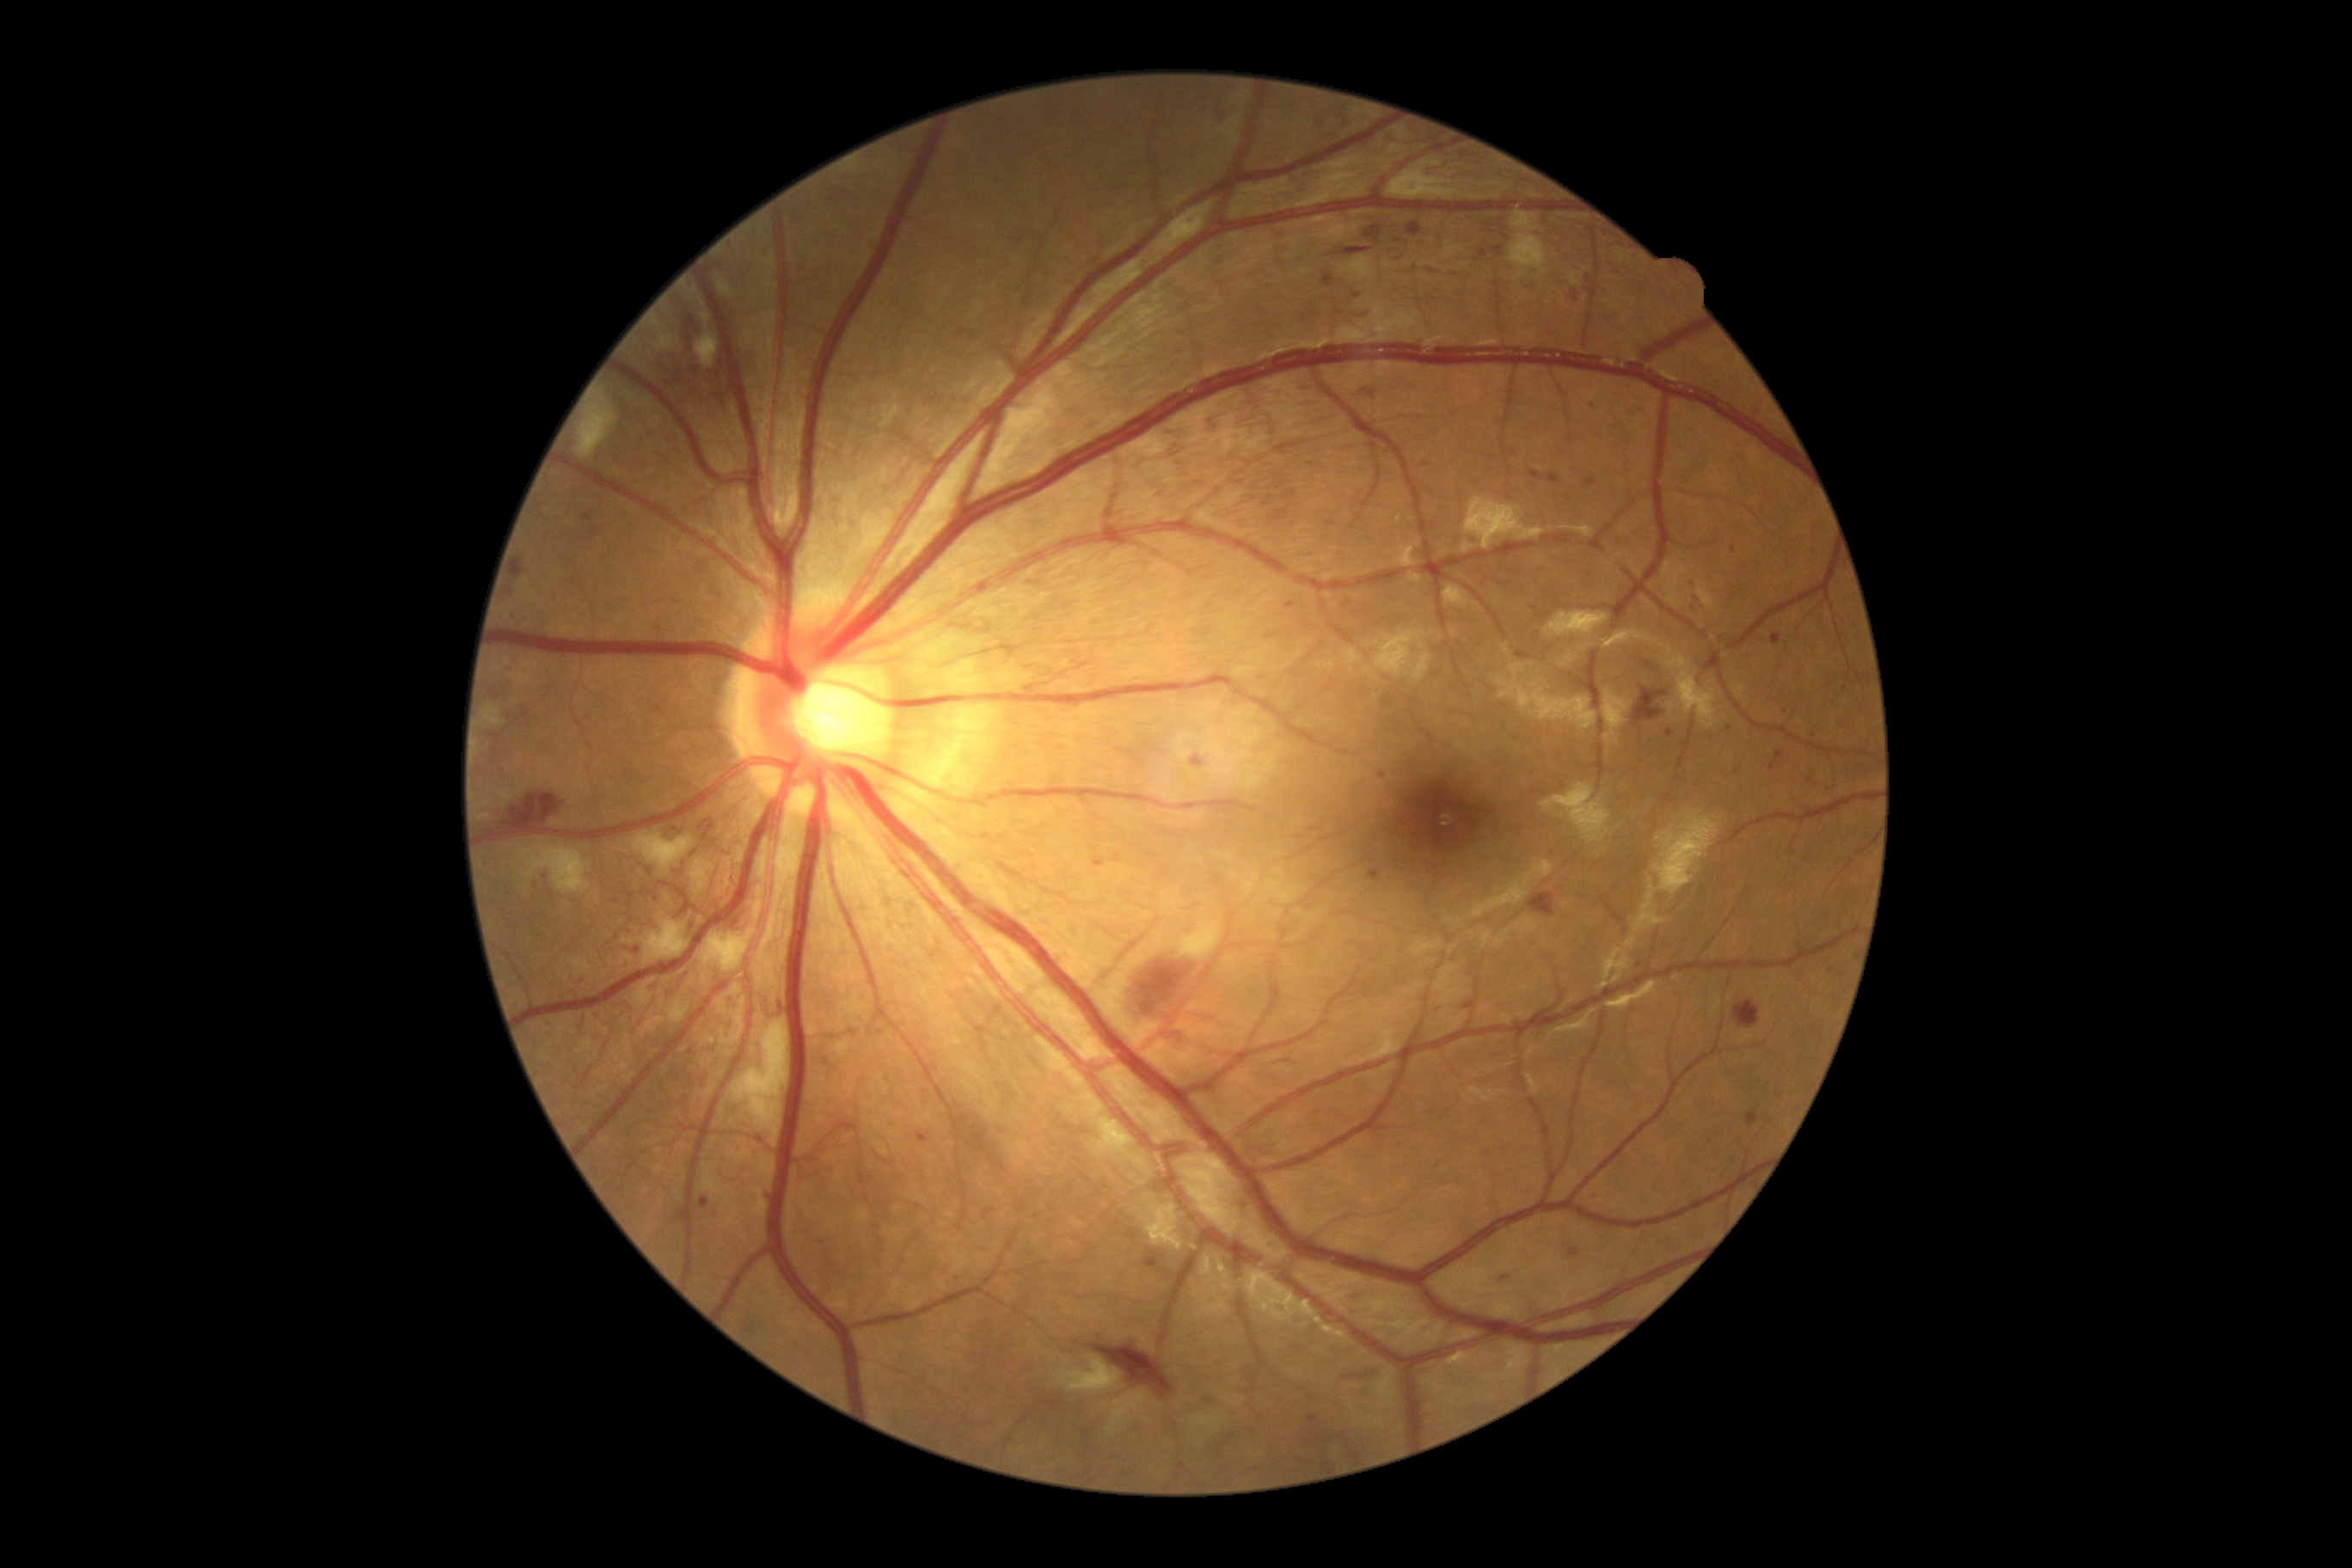

DR stage is 3/4
A subset of detected lesions:
HEs (continued): (left=1784, top=778, right=1794, bottom=790) | (left=1314, top=118, right=1328, bottom=132) | (left=487, top=680, right=518, bottom=702) | (left=1366, top=226, right=1381, bottom=238) | (left=1218, top=113, right=1227, bottom=118) | (left=1302, top=900, right=1316, bottom=916) | (left=1602, top=259, right=1622, bottom=276) | (left=625, top=928, right=634, bottom=938) | (left=1091, top=1344, right=1175, bottom=1399) | (left=1283, top=491, right=1297, bottom=501) | (left=1505, top=264, right=1516, bottom=273) | (left=1414, top=238, right=1426, bottom=252) | (left=1615, top=243, right=1626, bottom=254) | (left=591, top=529, right=601, bottom=536) | (left=1567, top=288, right=1583, bottom=305)
Small HEs near 510, 717 | 880, 1032 | 1710, 1141 | 1357, 296